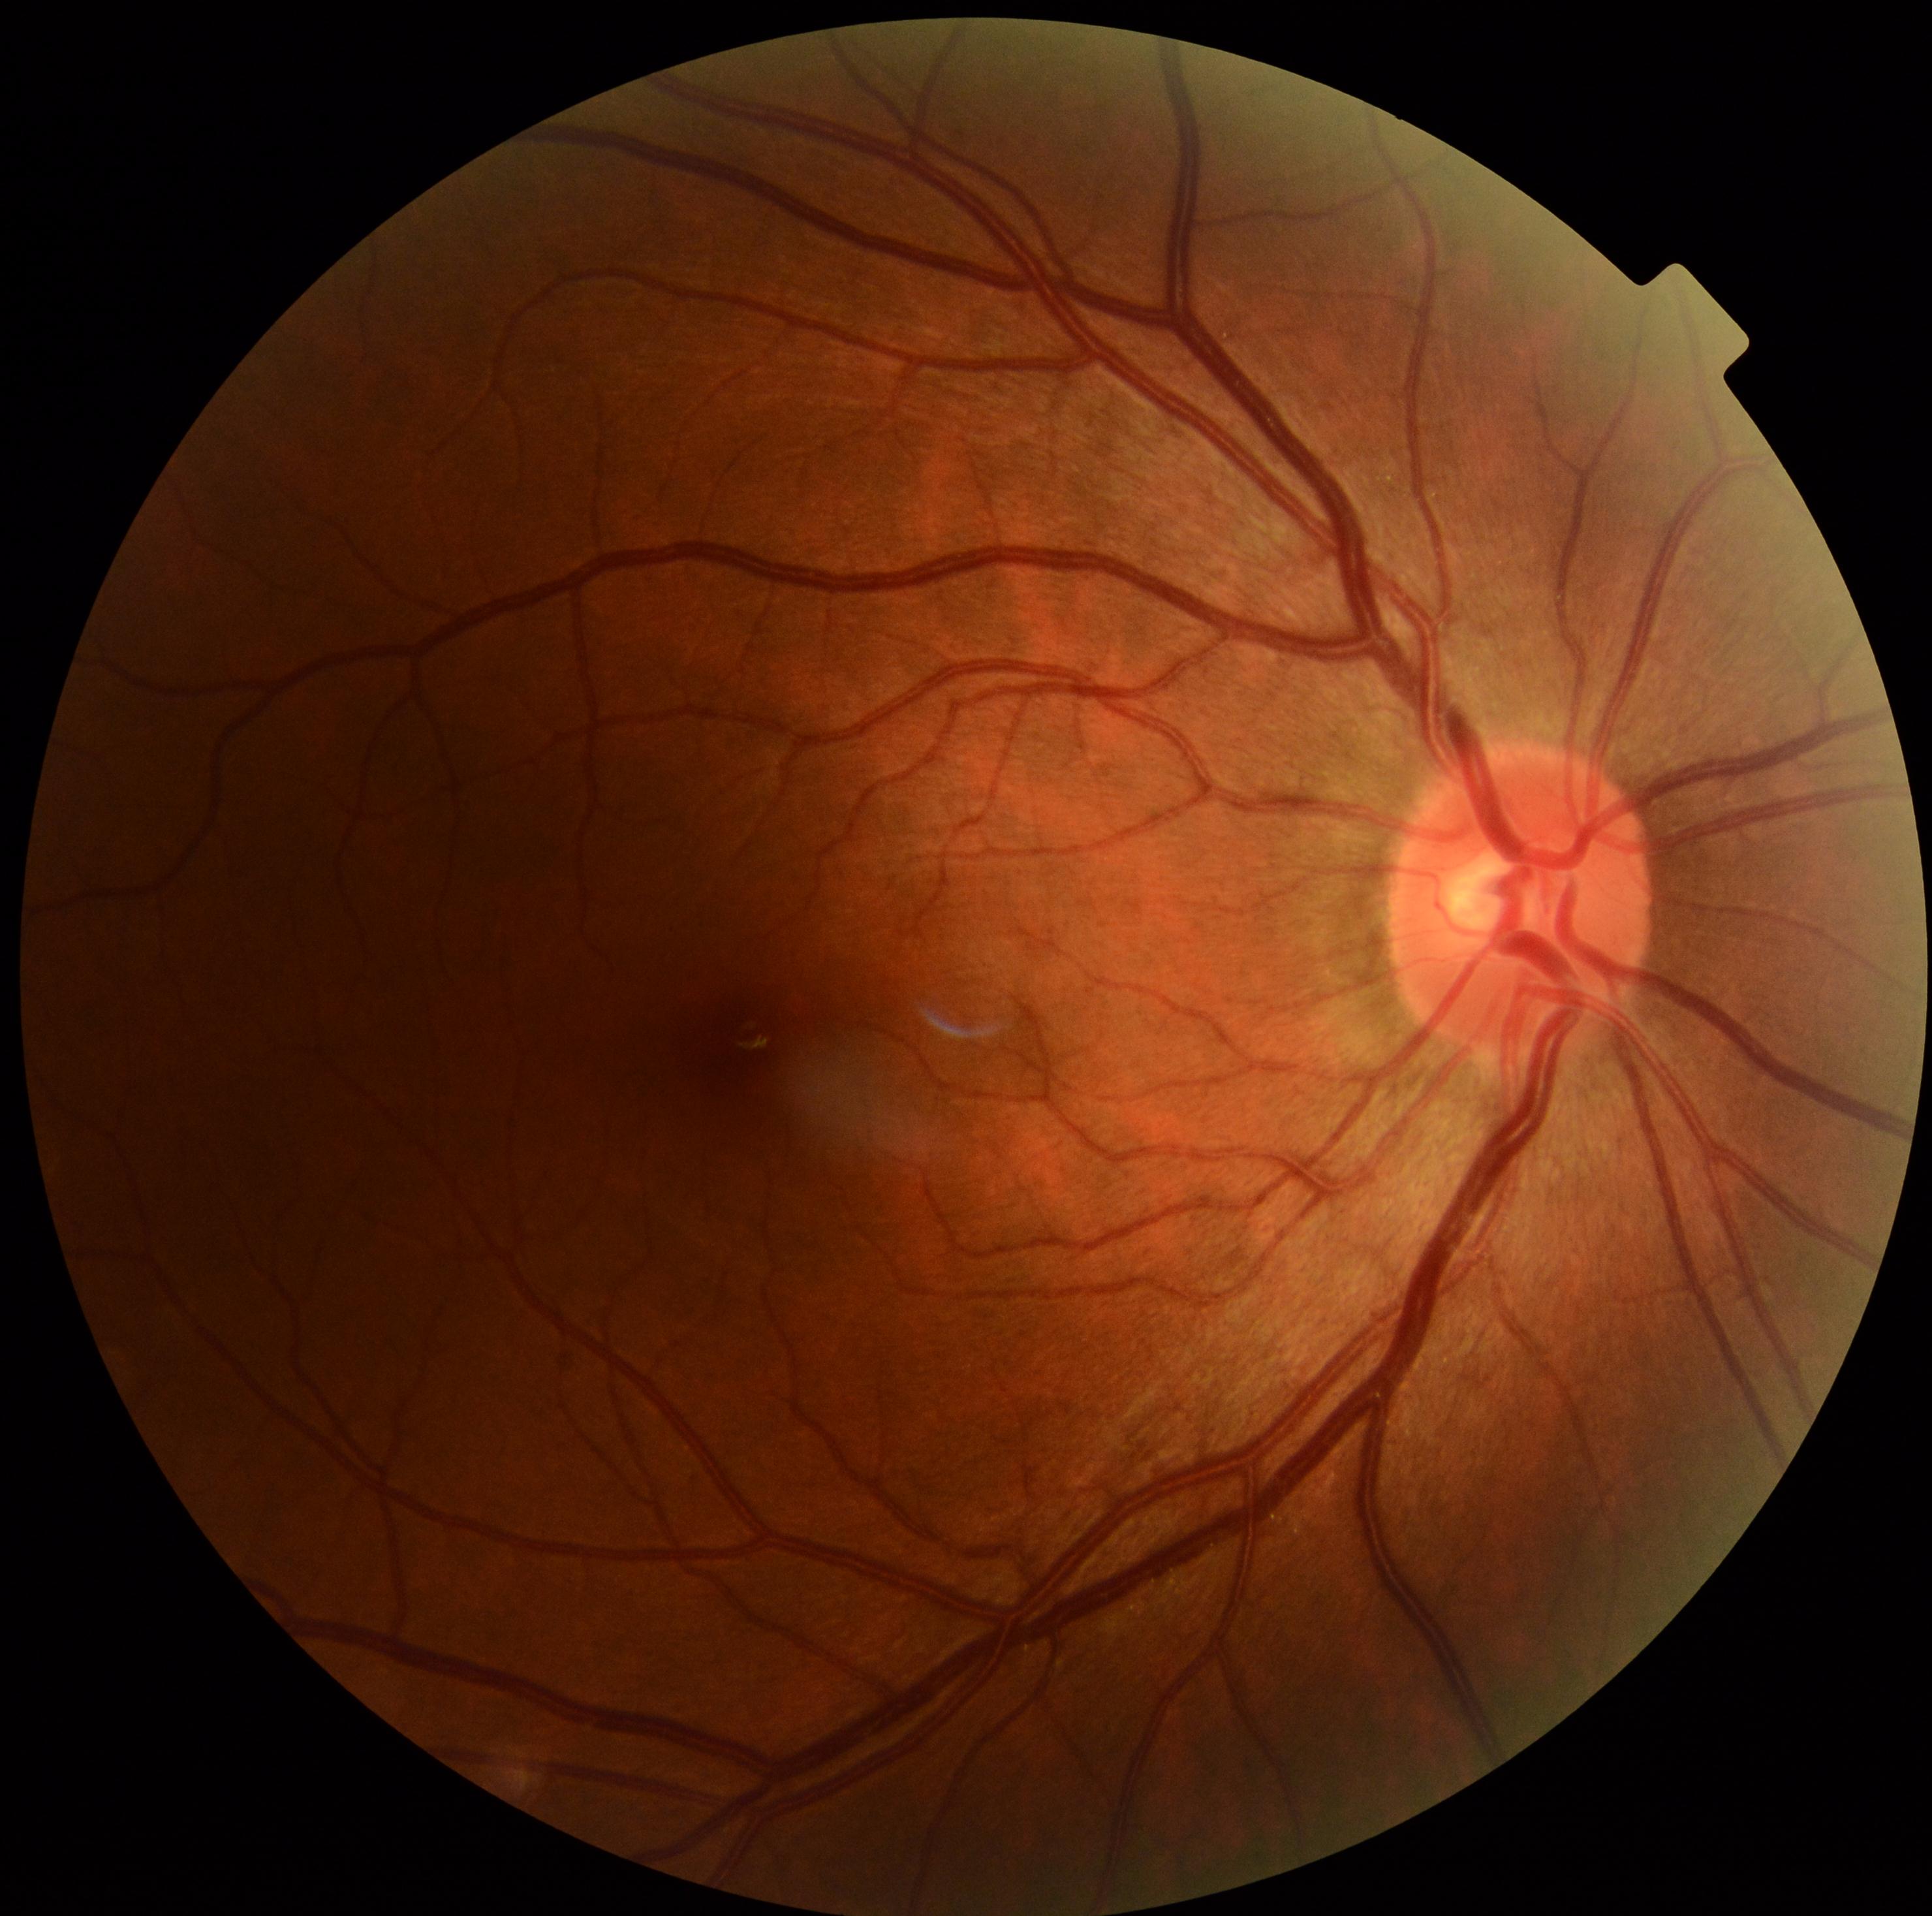 Diabetic retinopathy severity: 0/4. No diabetic retinal disease findings.